45° FOV: 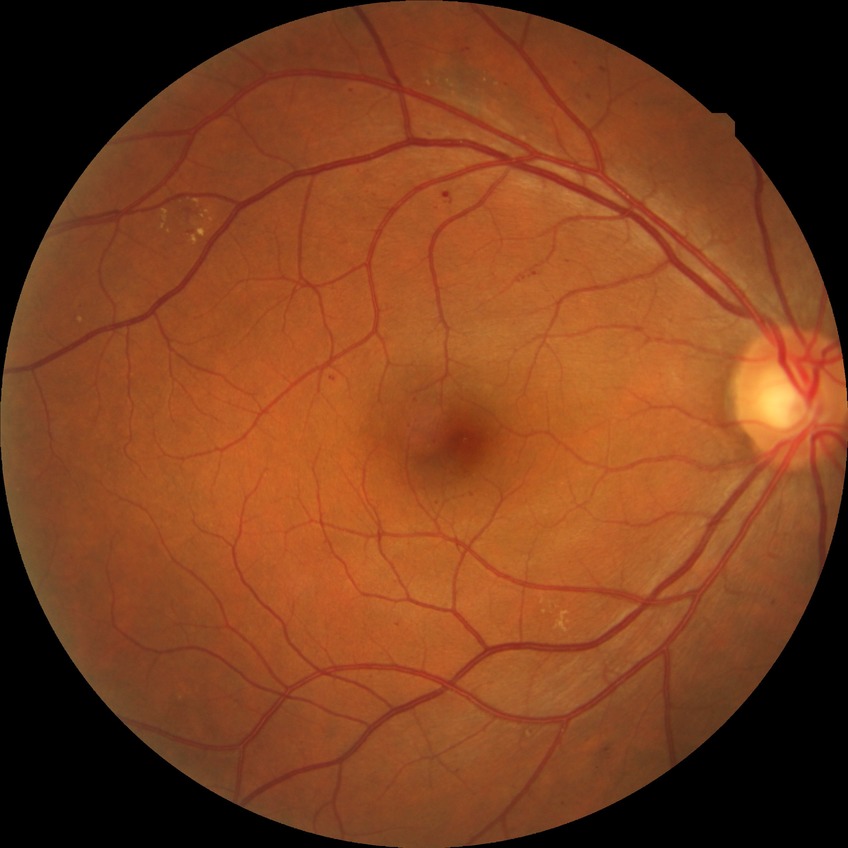

davis_grade: SDR (simple diabetic retinopathy)